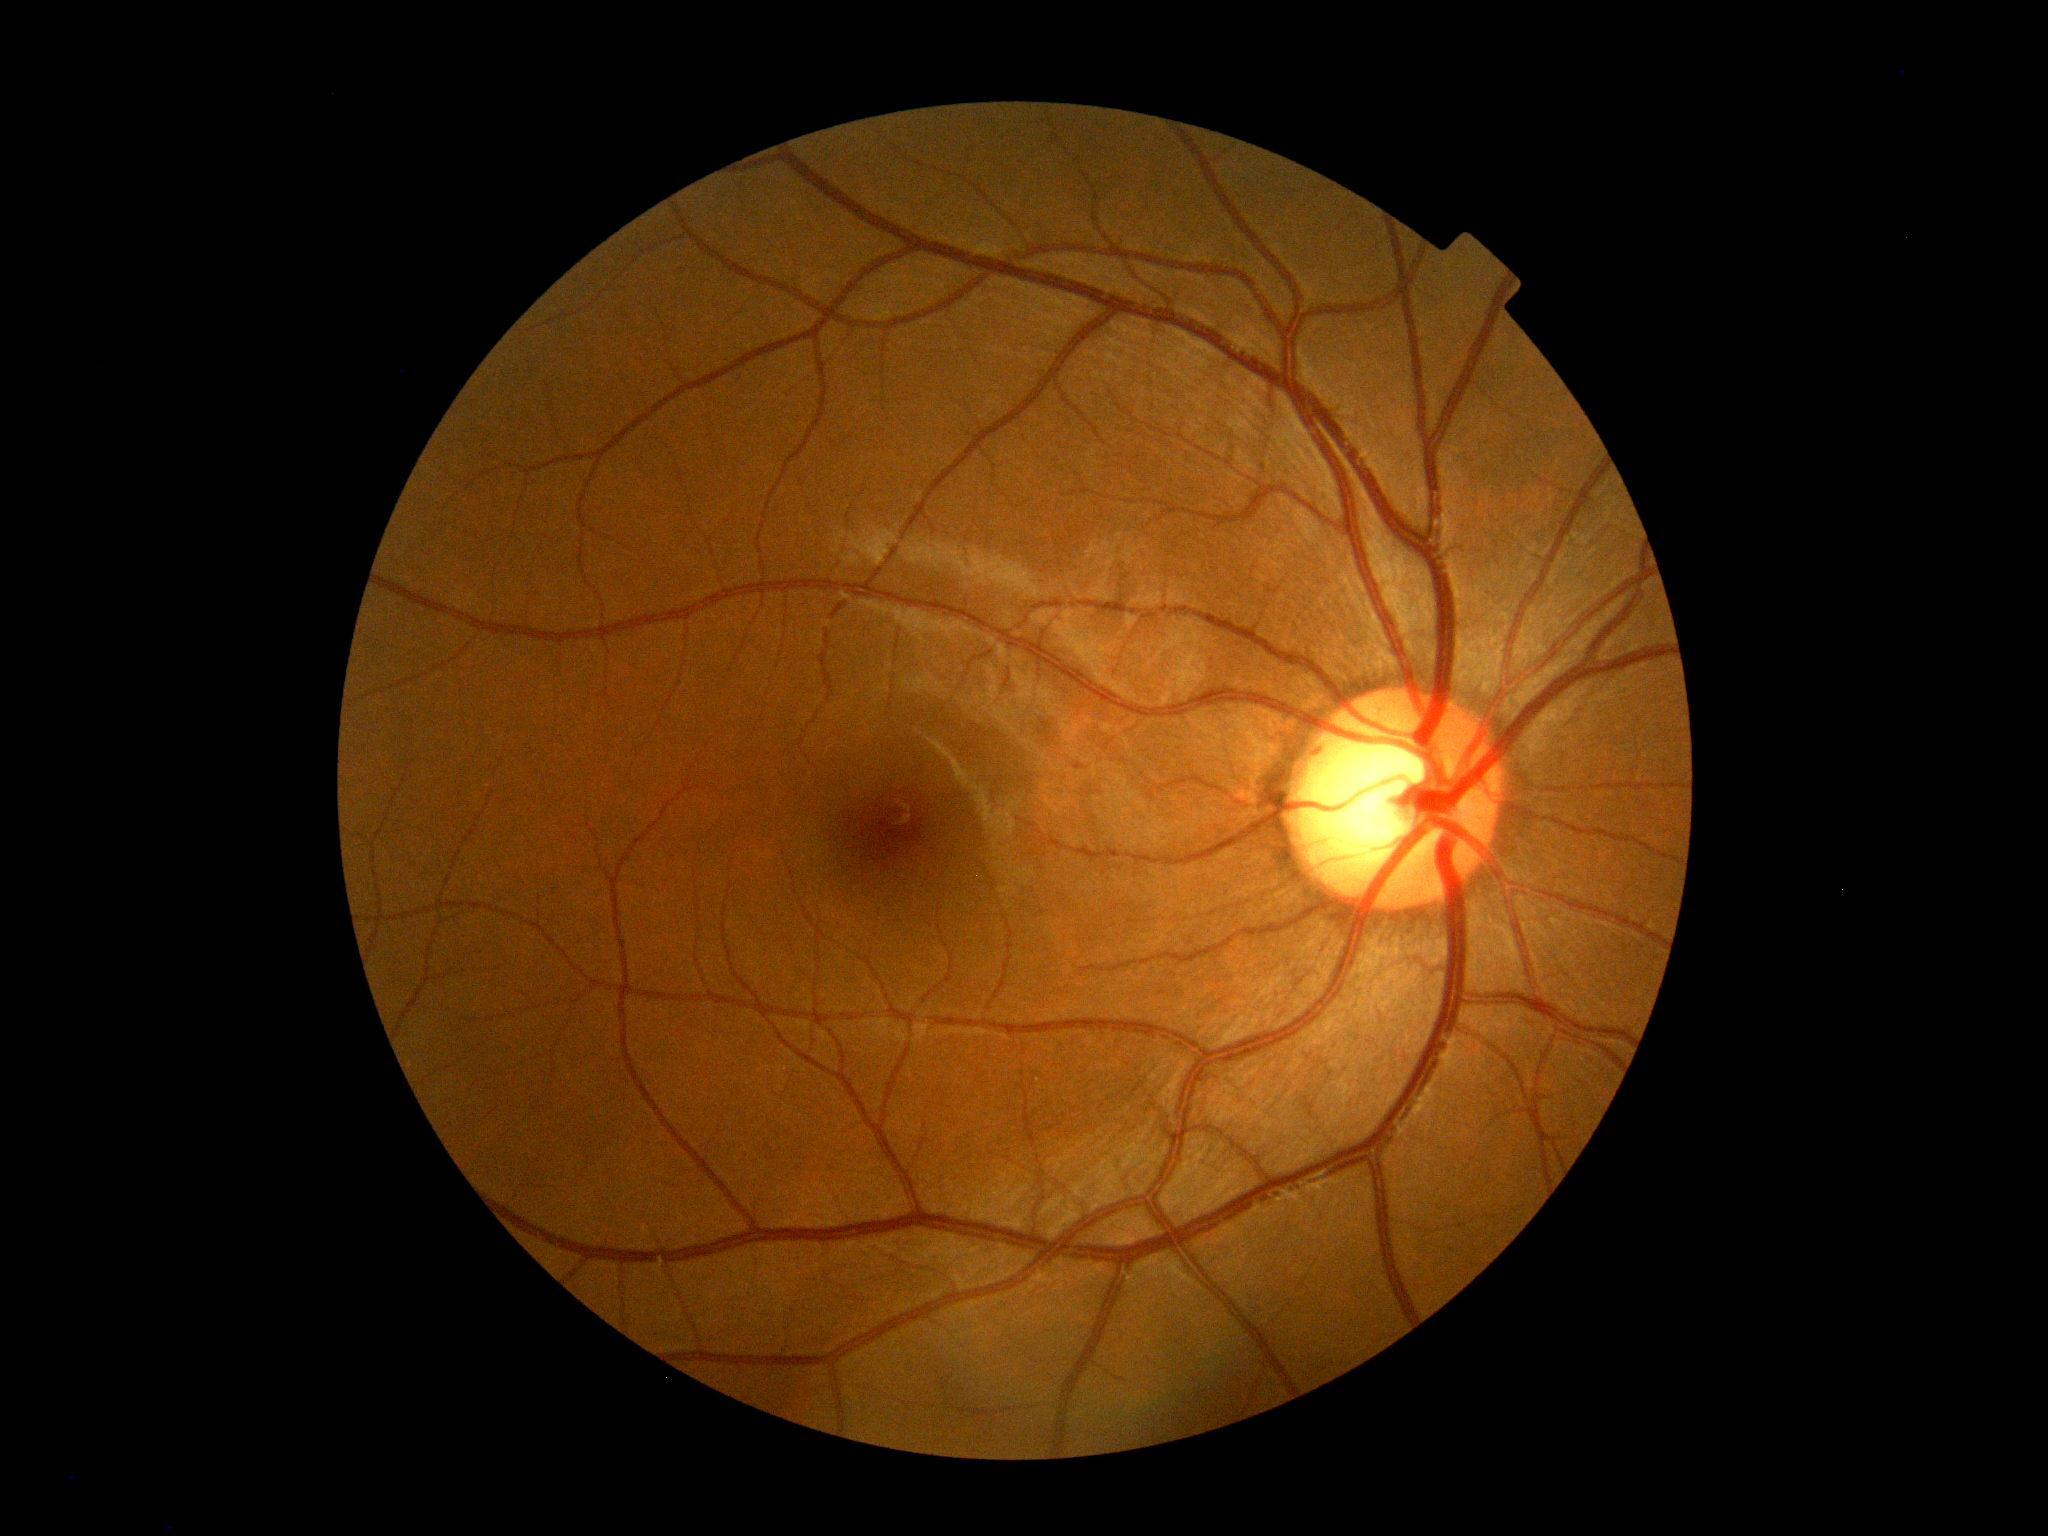
DR stage: 0/4.